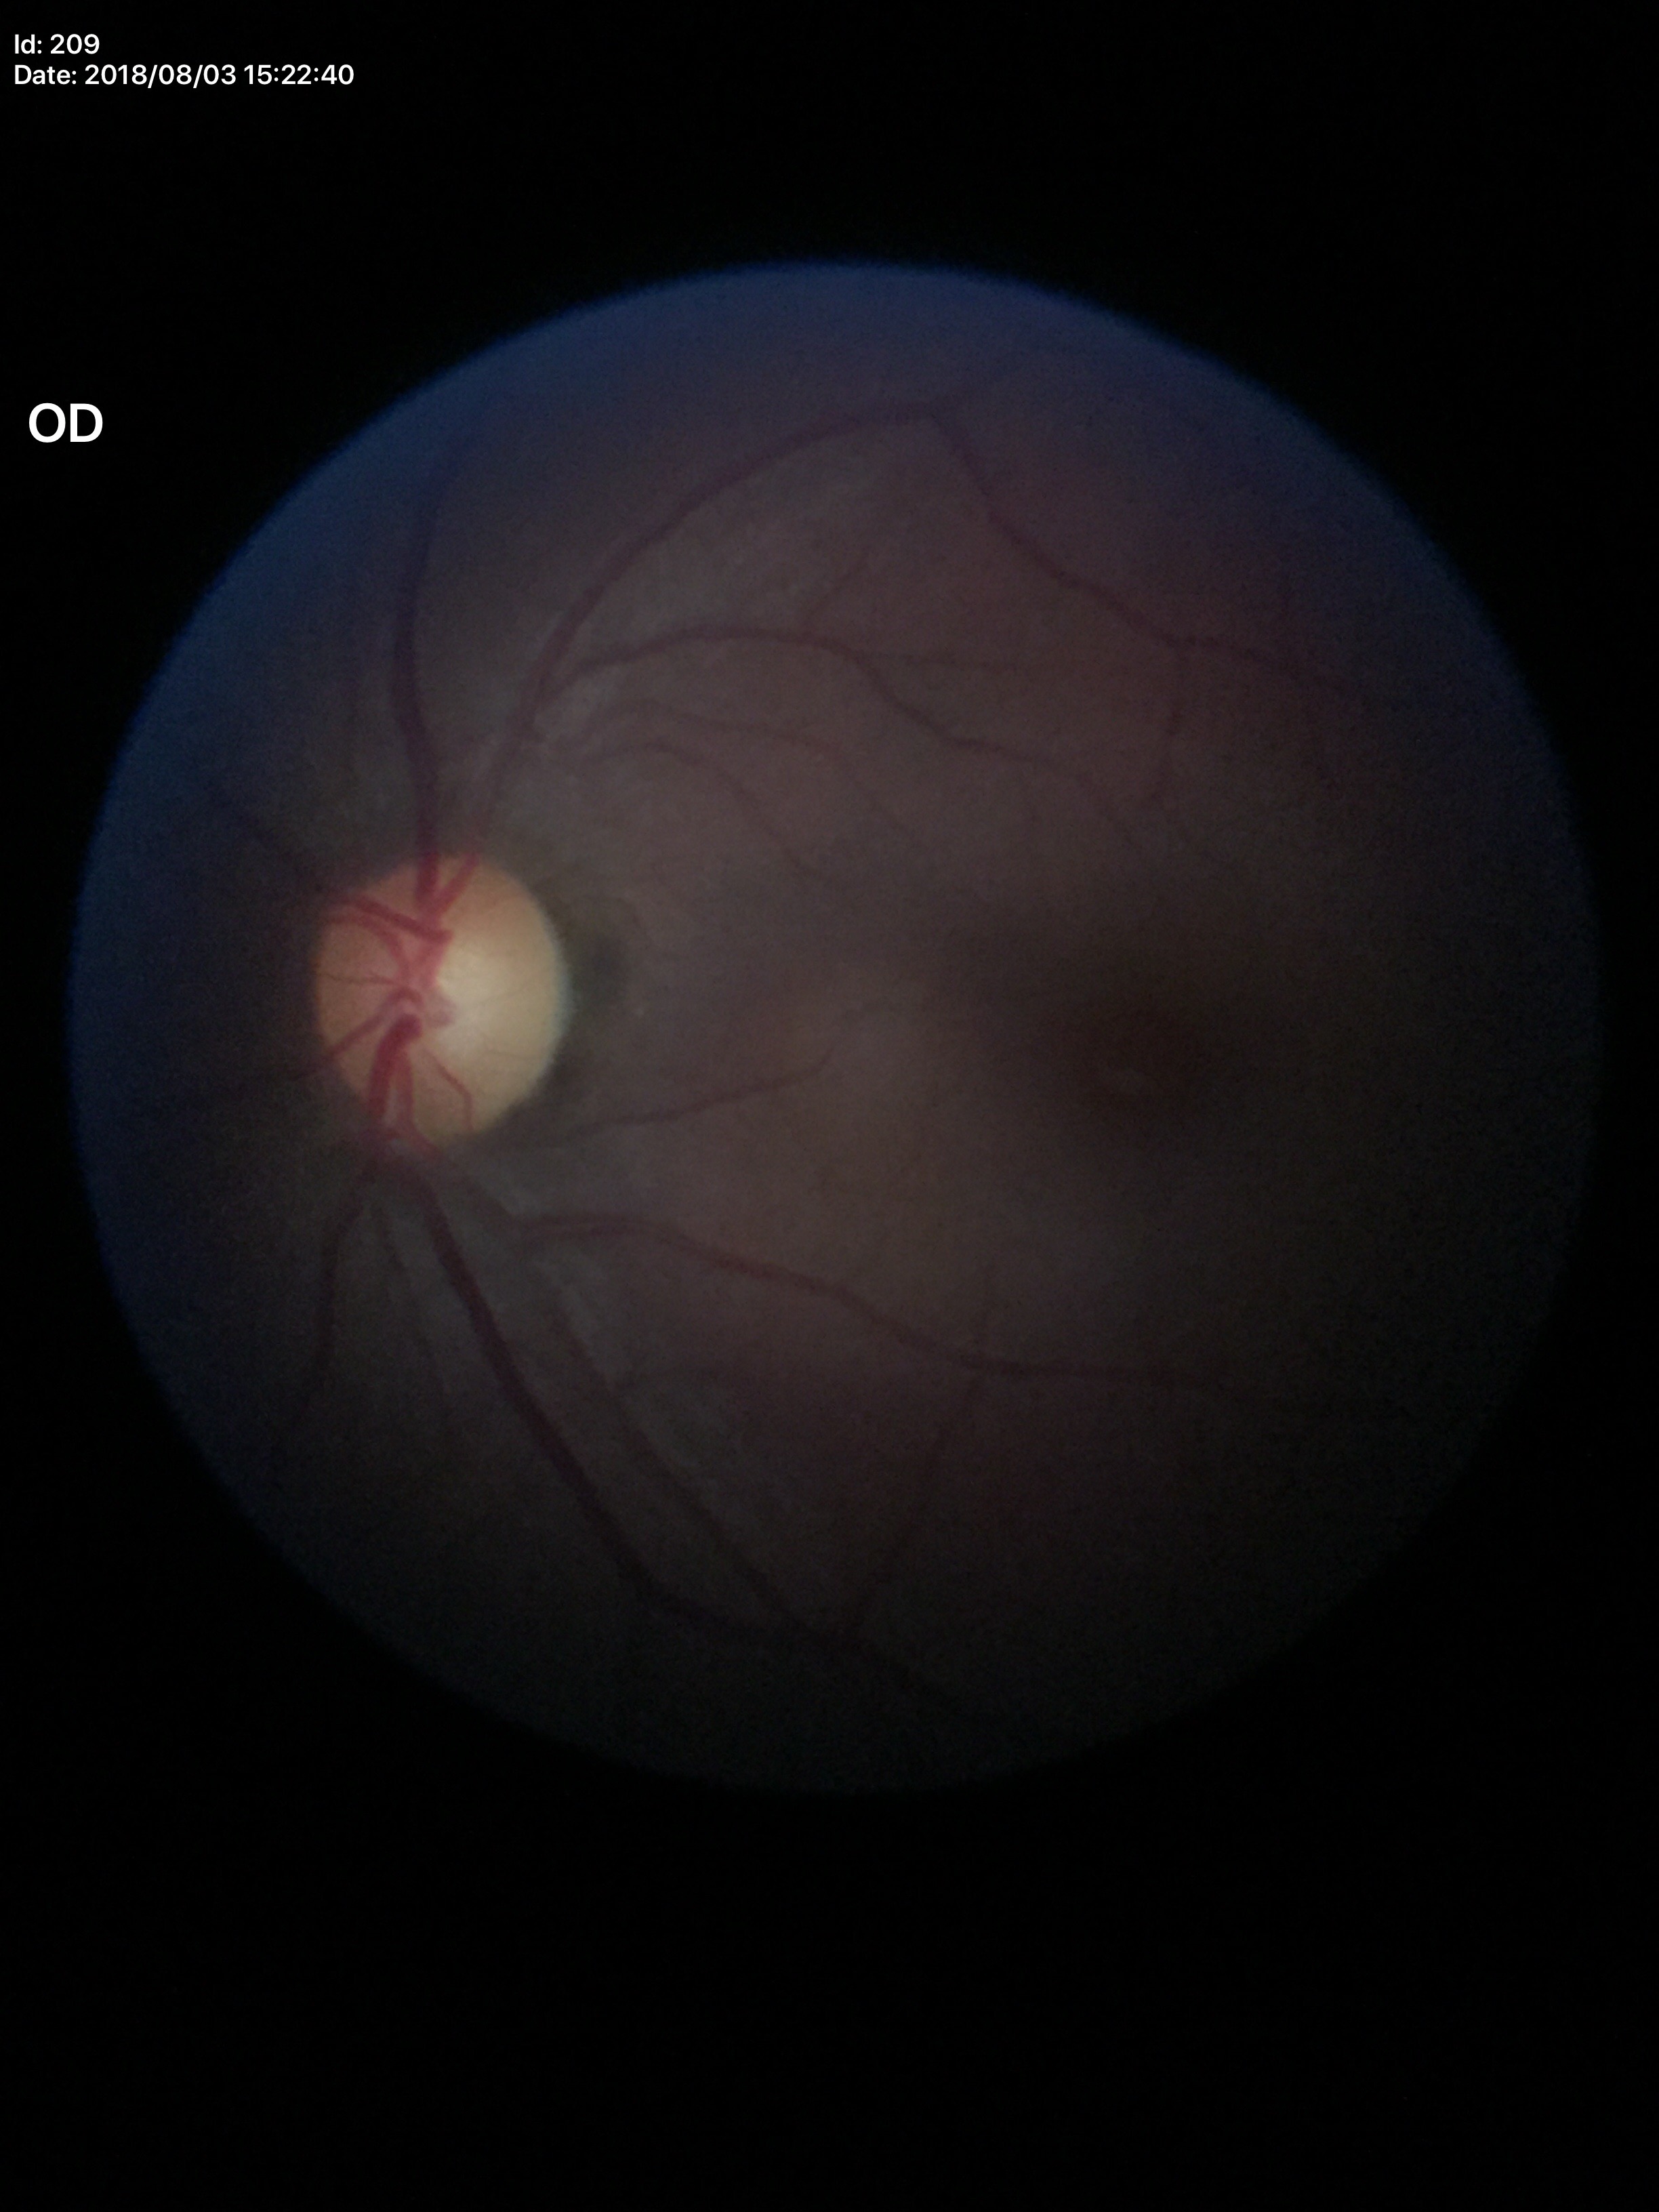
vertical cup-disc ratio (VCDR): 0.52 | Glaucoma impression: not suspect